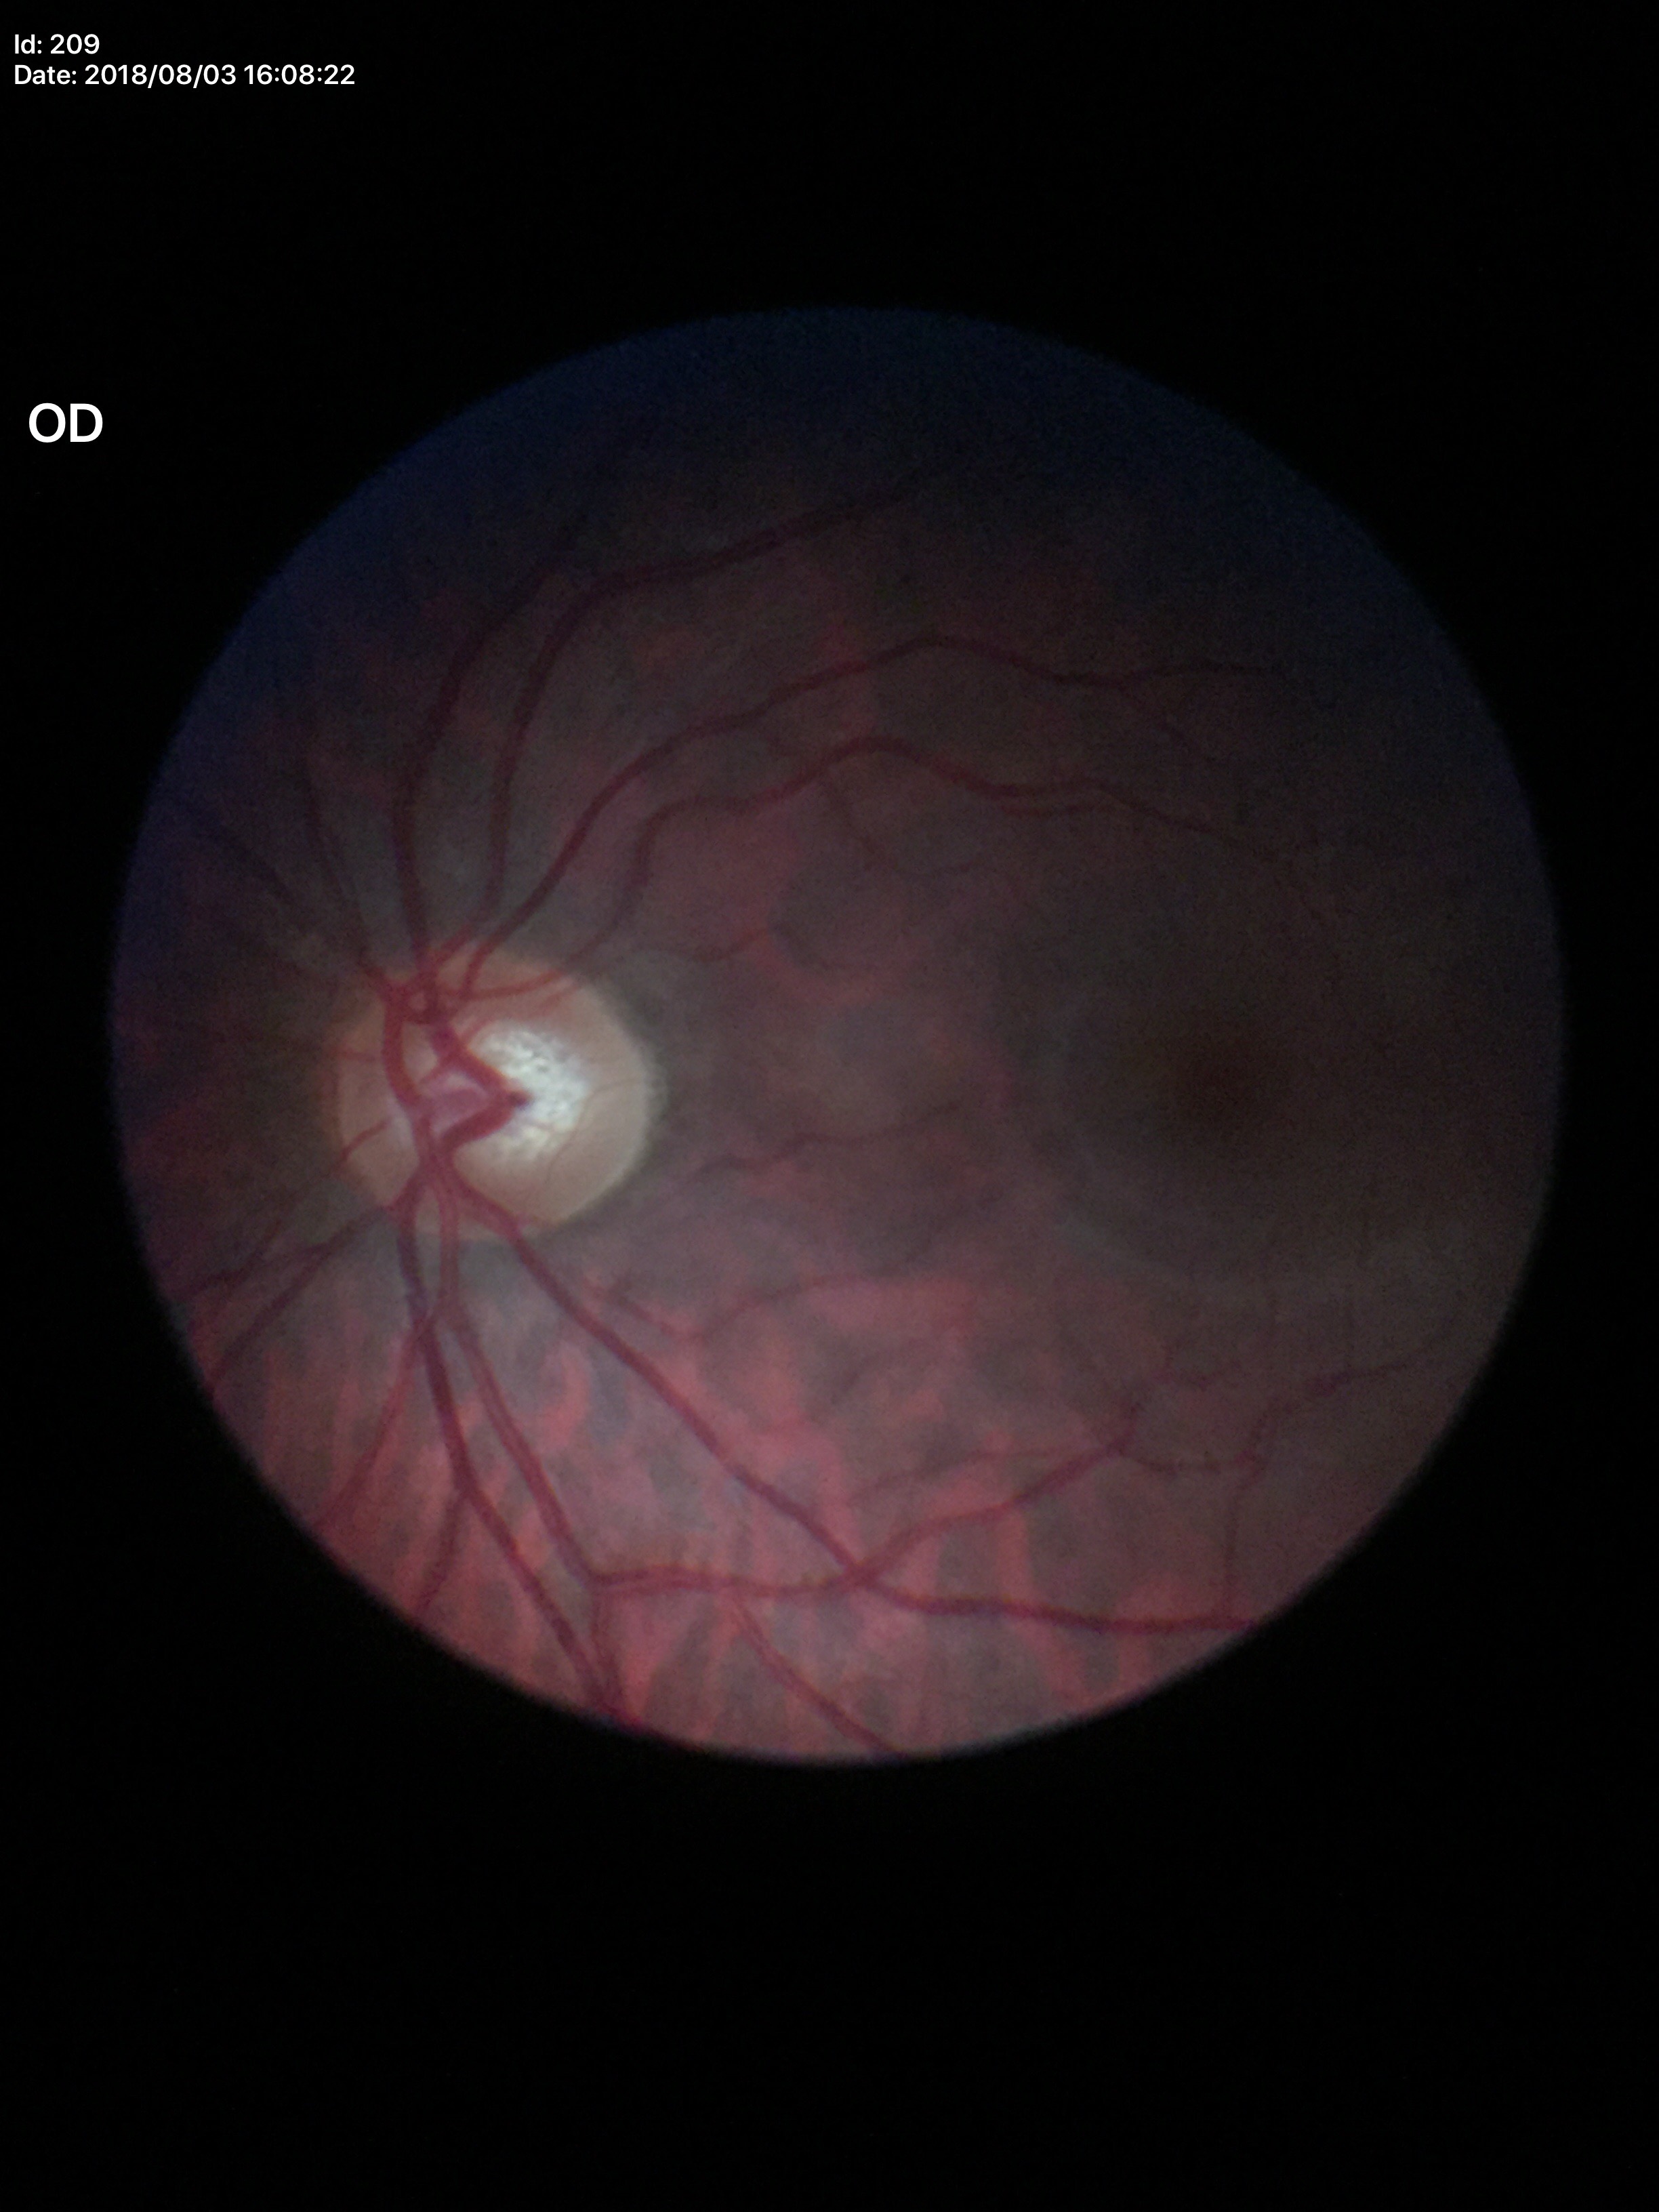

Glaucoma impression: not suspect.
Vertical CDR is 0.59.